2352x1568; FOV: 45 degrees:
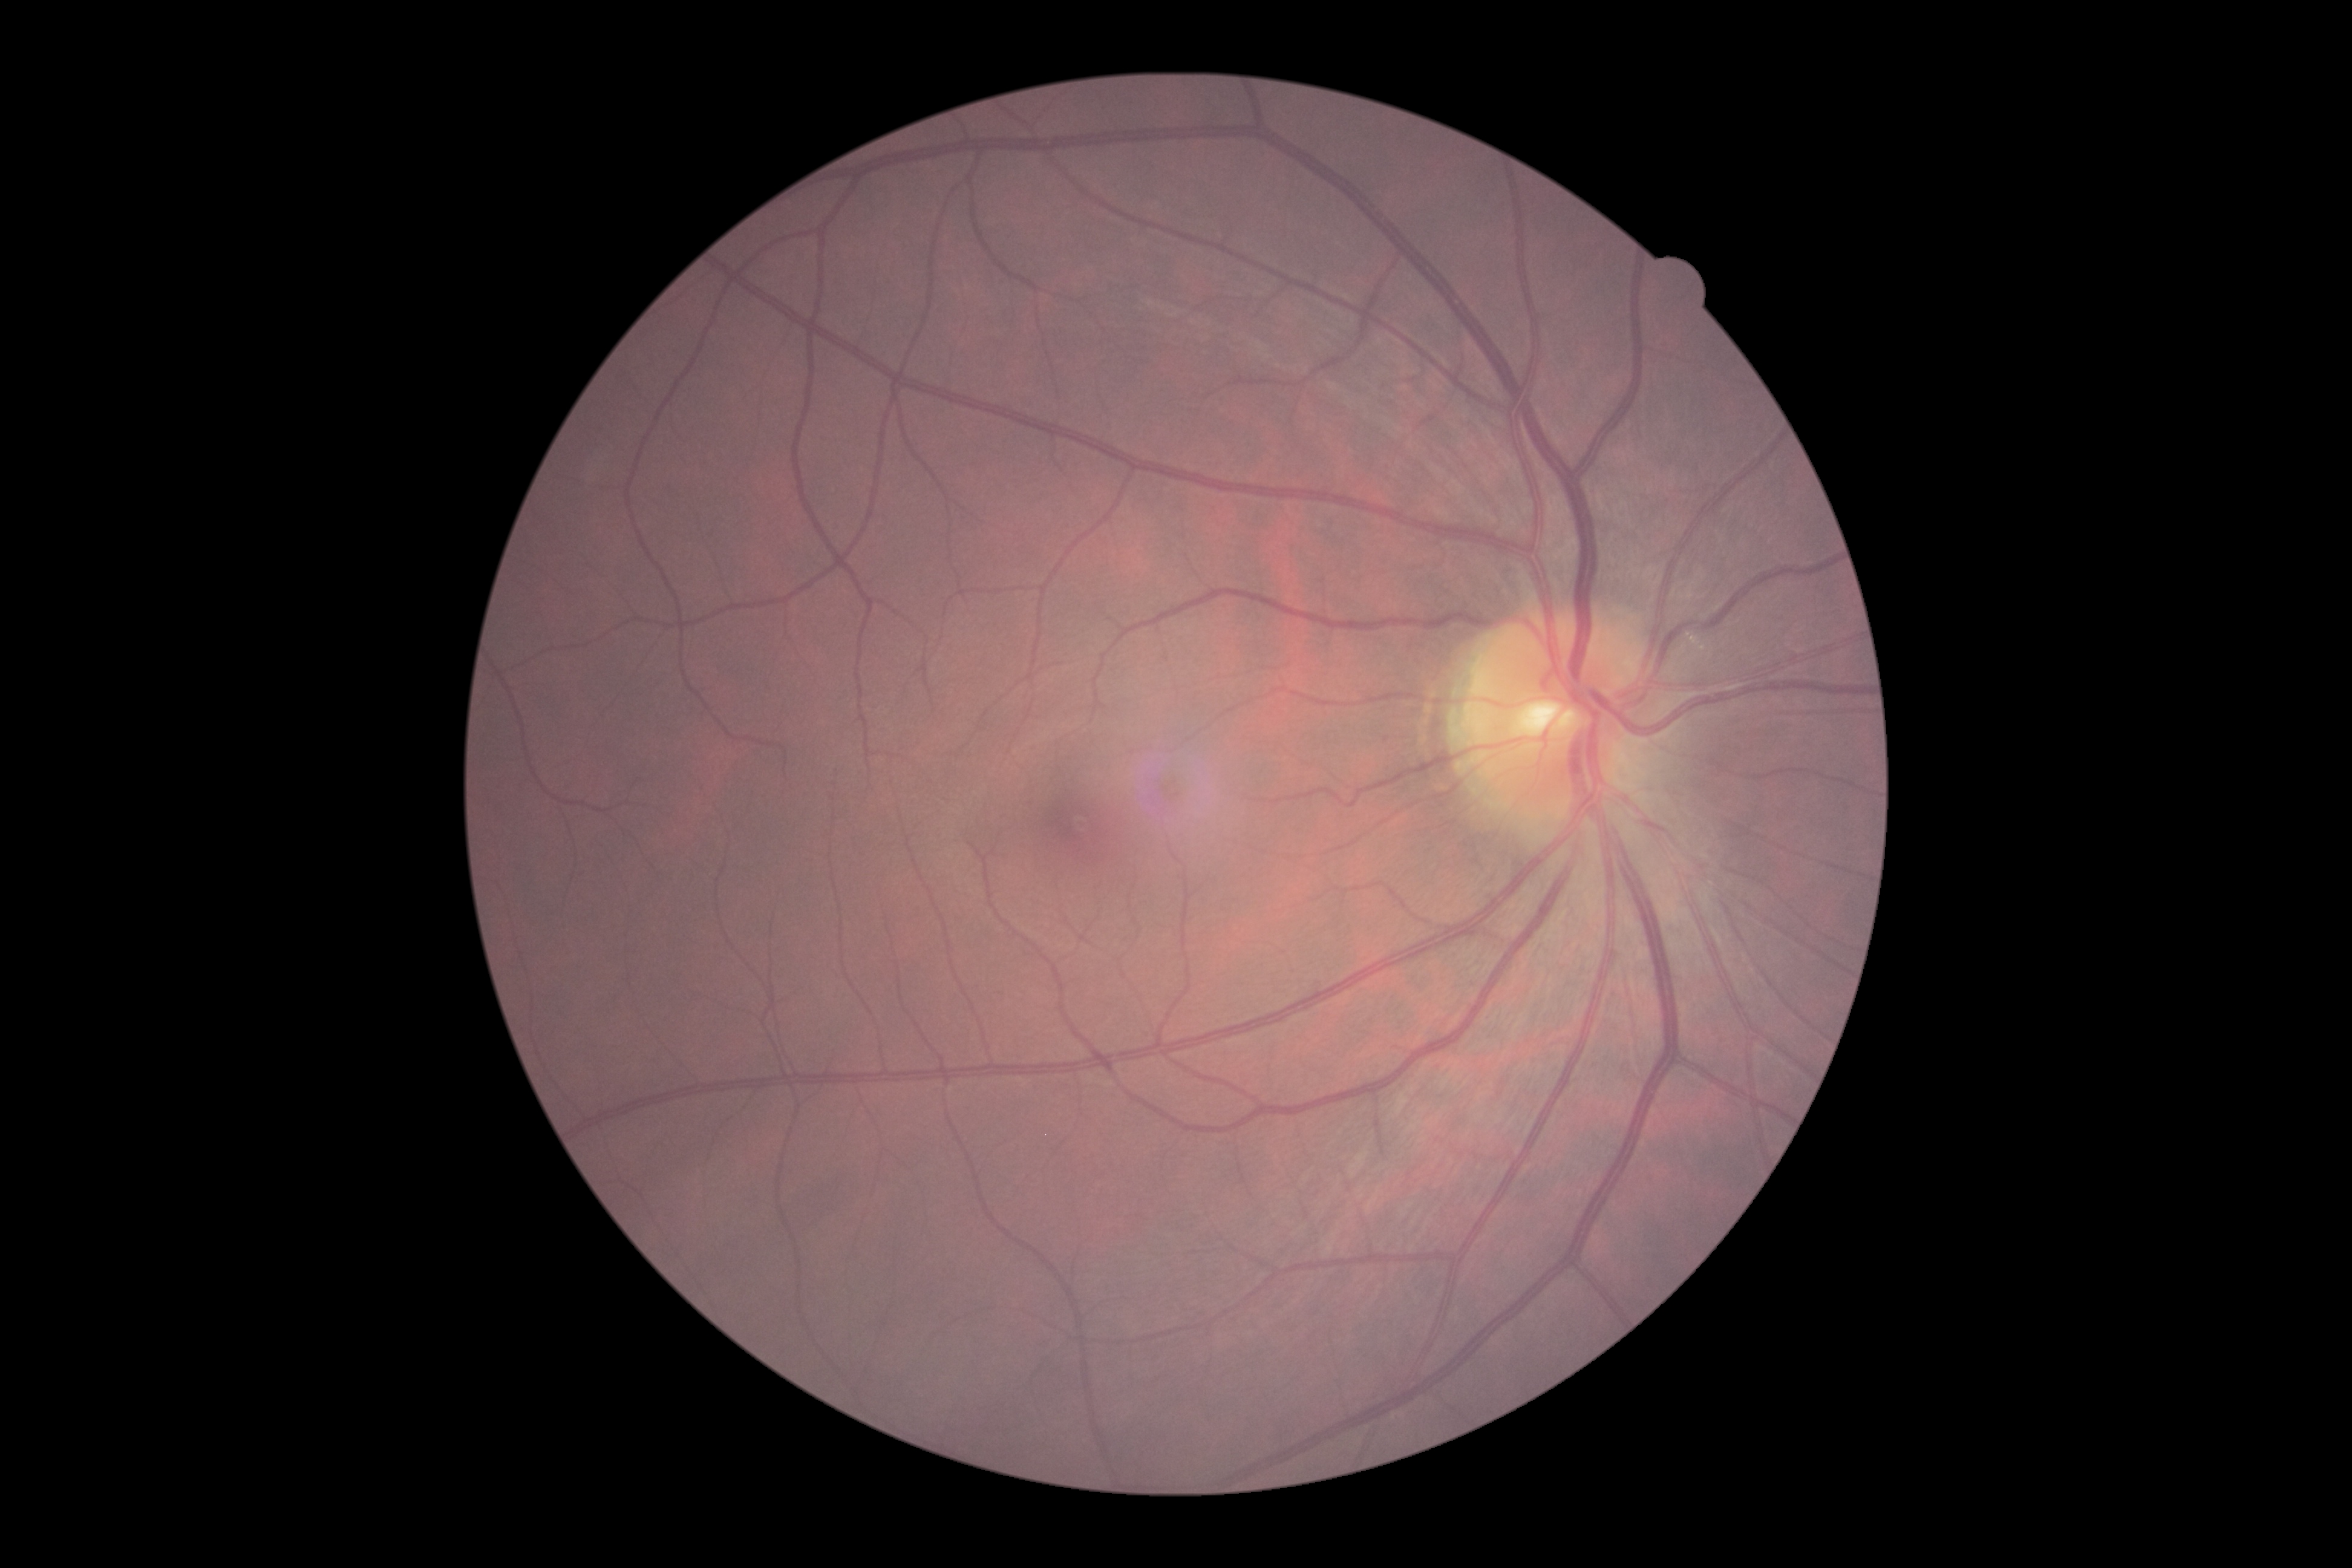 DR severity=no apparent retinopathy (grade 0) — no visible signs of diabetic retinopathy.